Captured with the Phoenix ICON (100° field of view) · infant wide-field fundus photograph
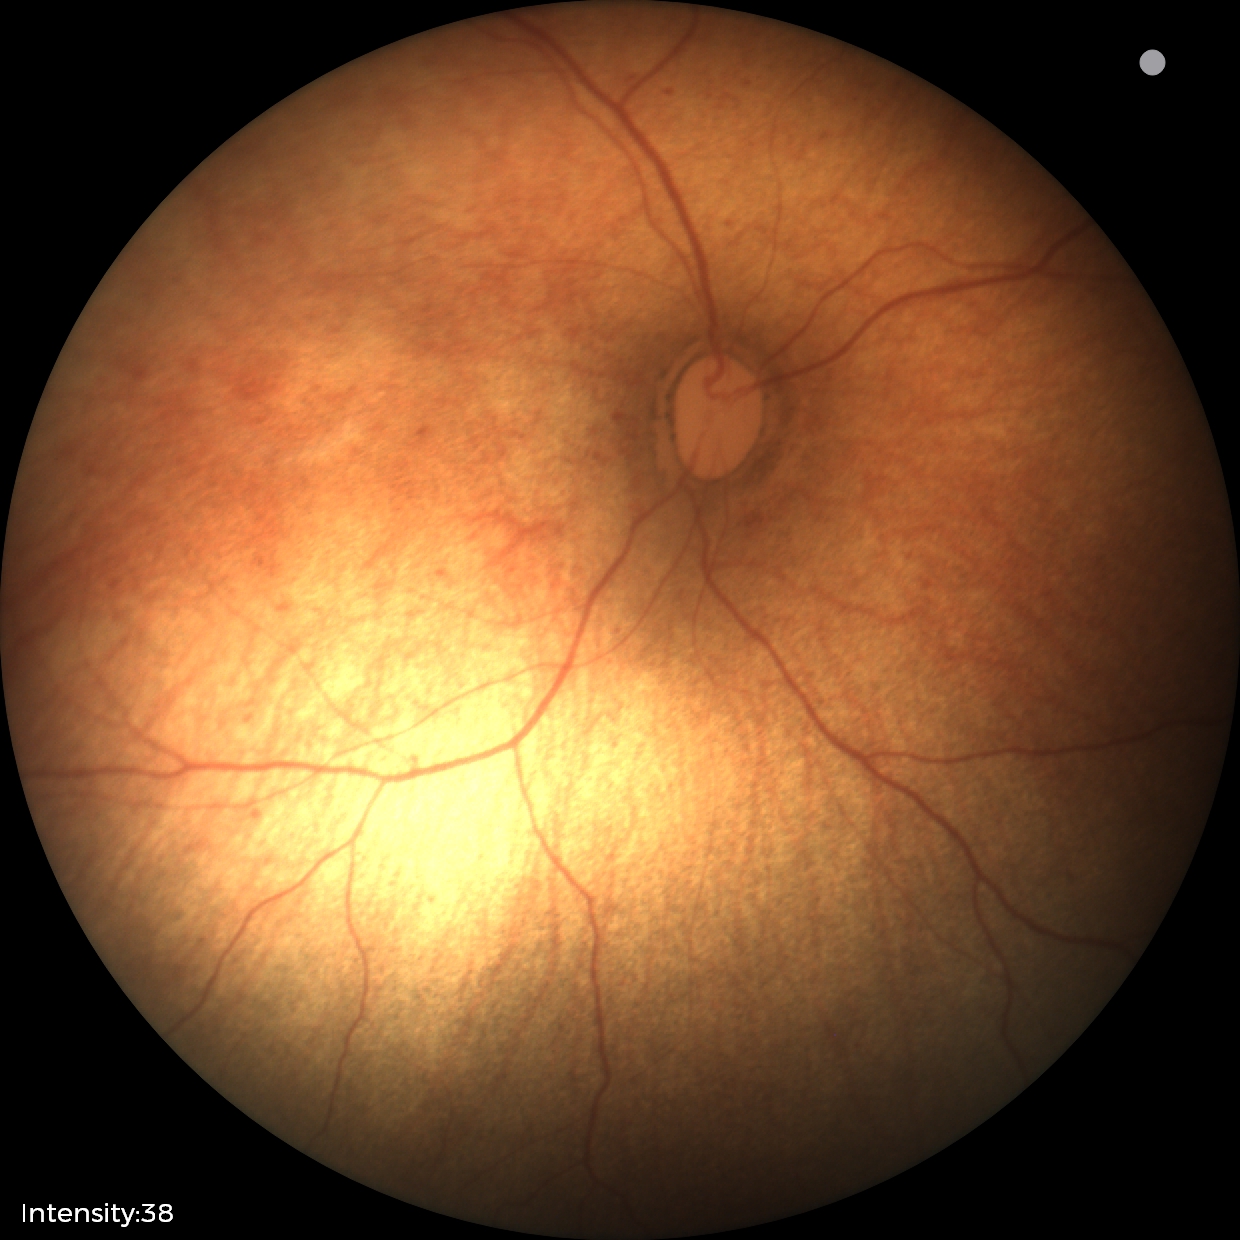

Physiological retinal appearance for postconceptual age.